Image size 1240x1240. Acquired on the Phoenix ICON. Pediatric retinal photograph (wide-field): 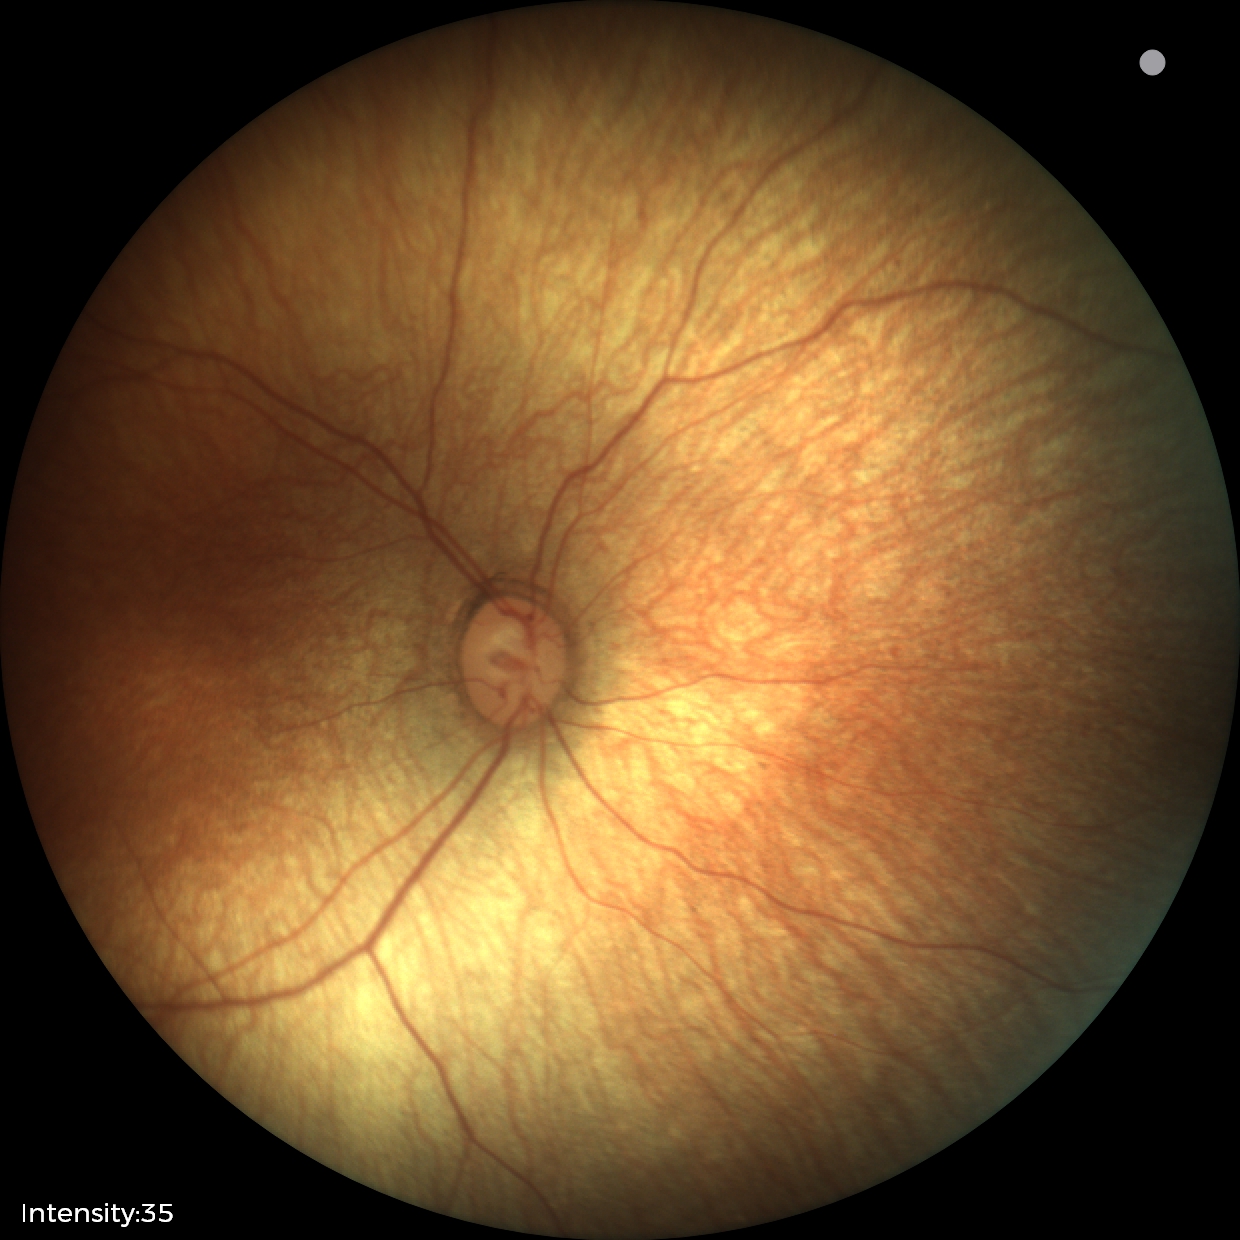 Q: What is the screening diagnosis?
A: no abnormal retinal findings